Camera: Nidek AFC-330.
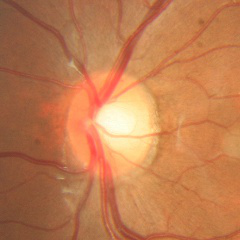

Diagnosis: no glaucomatous findings.